Color fundus photograph — 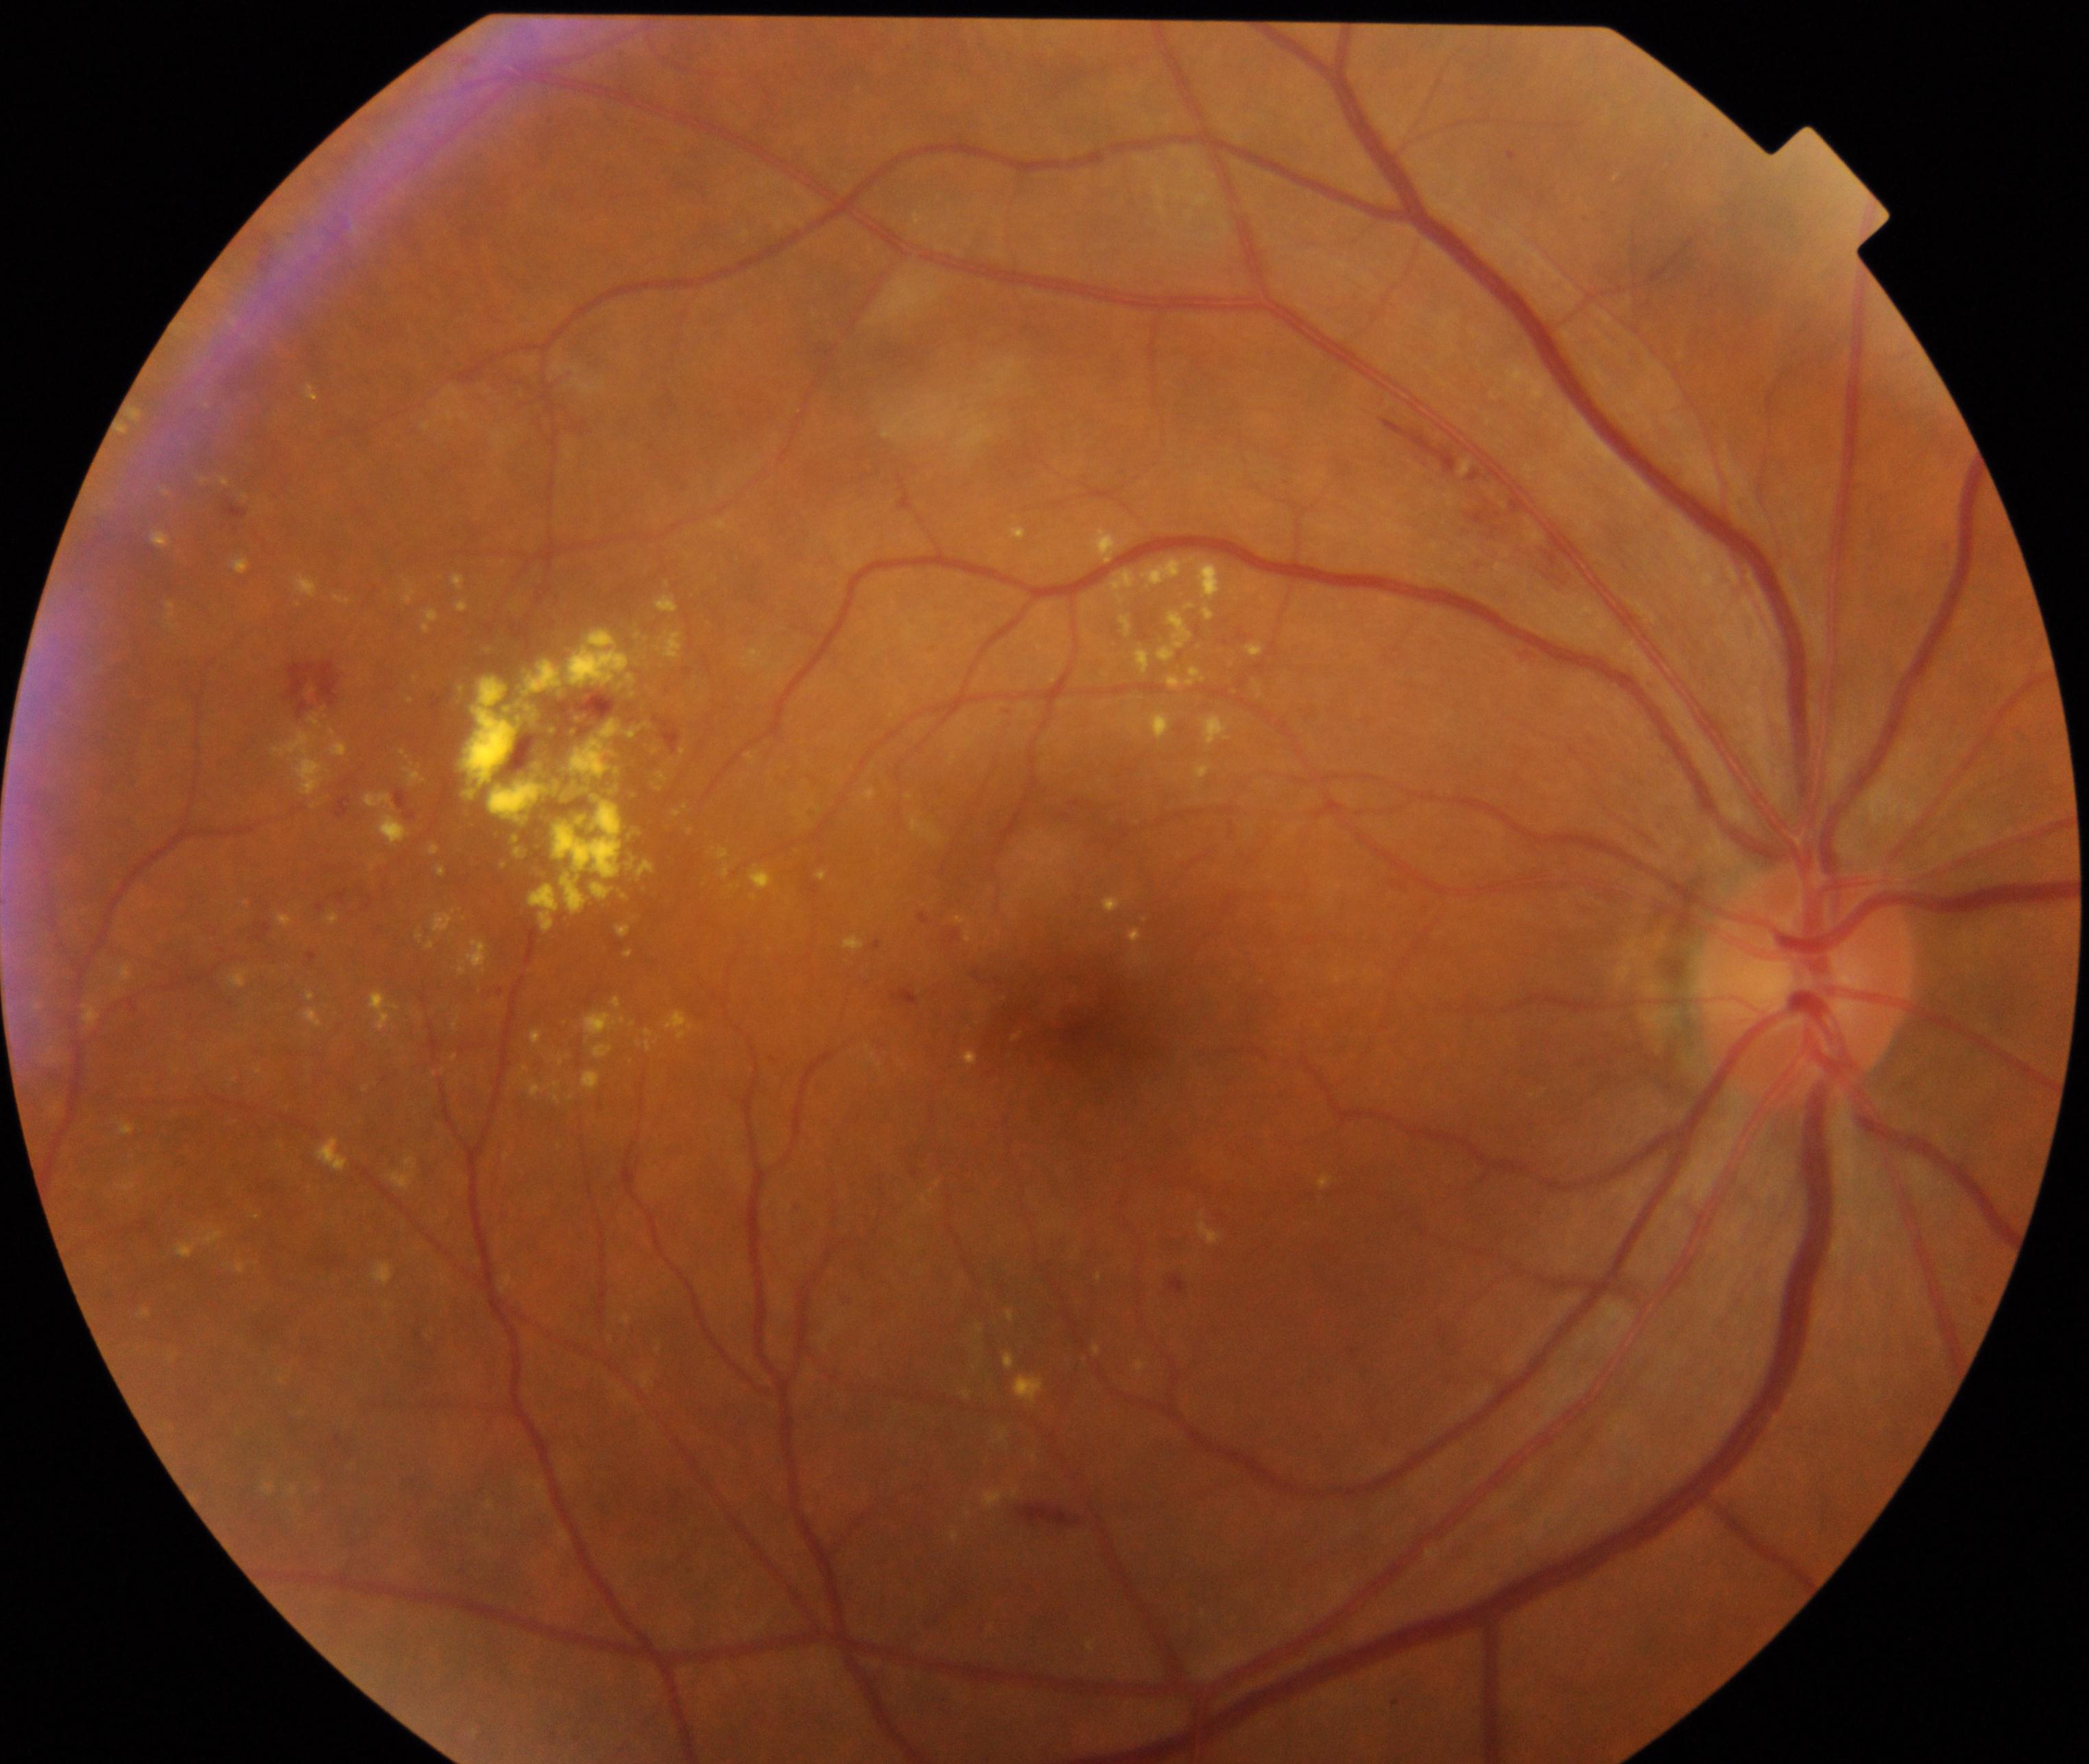
The image shows moderate non-proliferative diabetic retinopathy. Typically showing microaneurysms with dot and blot hemorrhages or hard exudates, less than severe non-proliferative diabetic retinopathy, and/or with diabetic macular edema.